Image size 1932x1932. Color fundus photograph
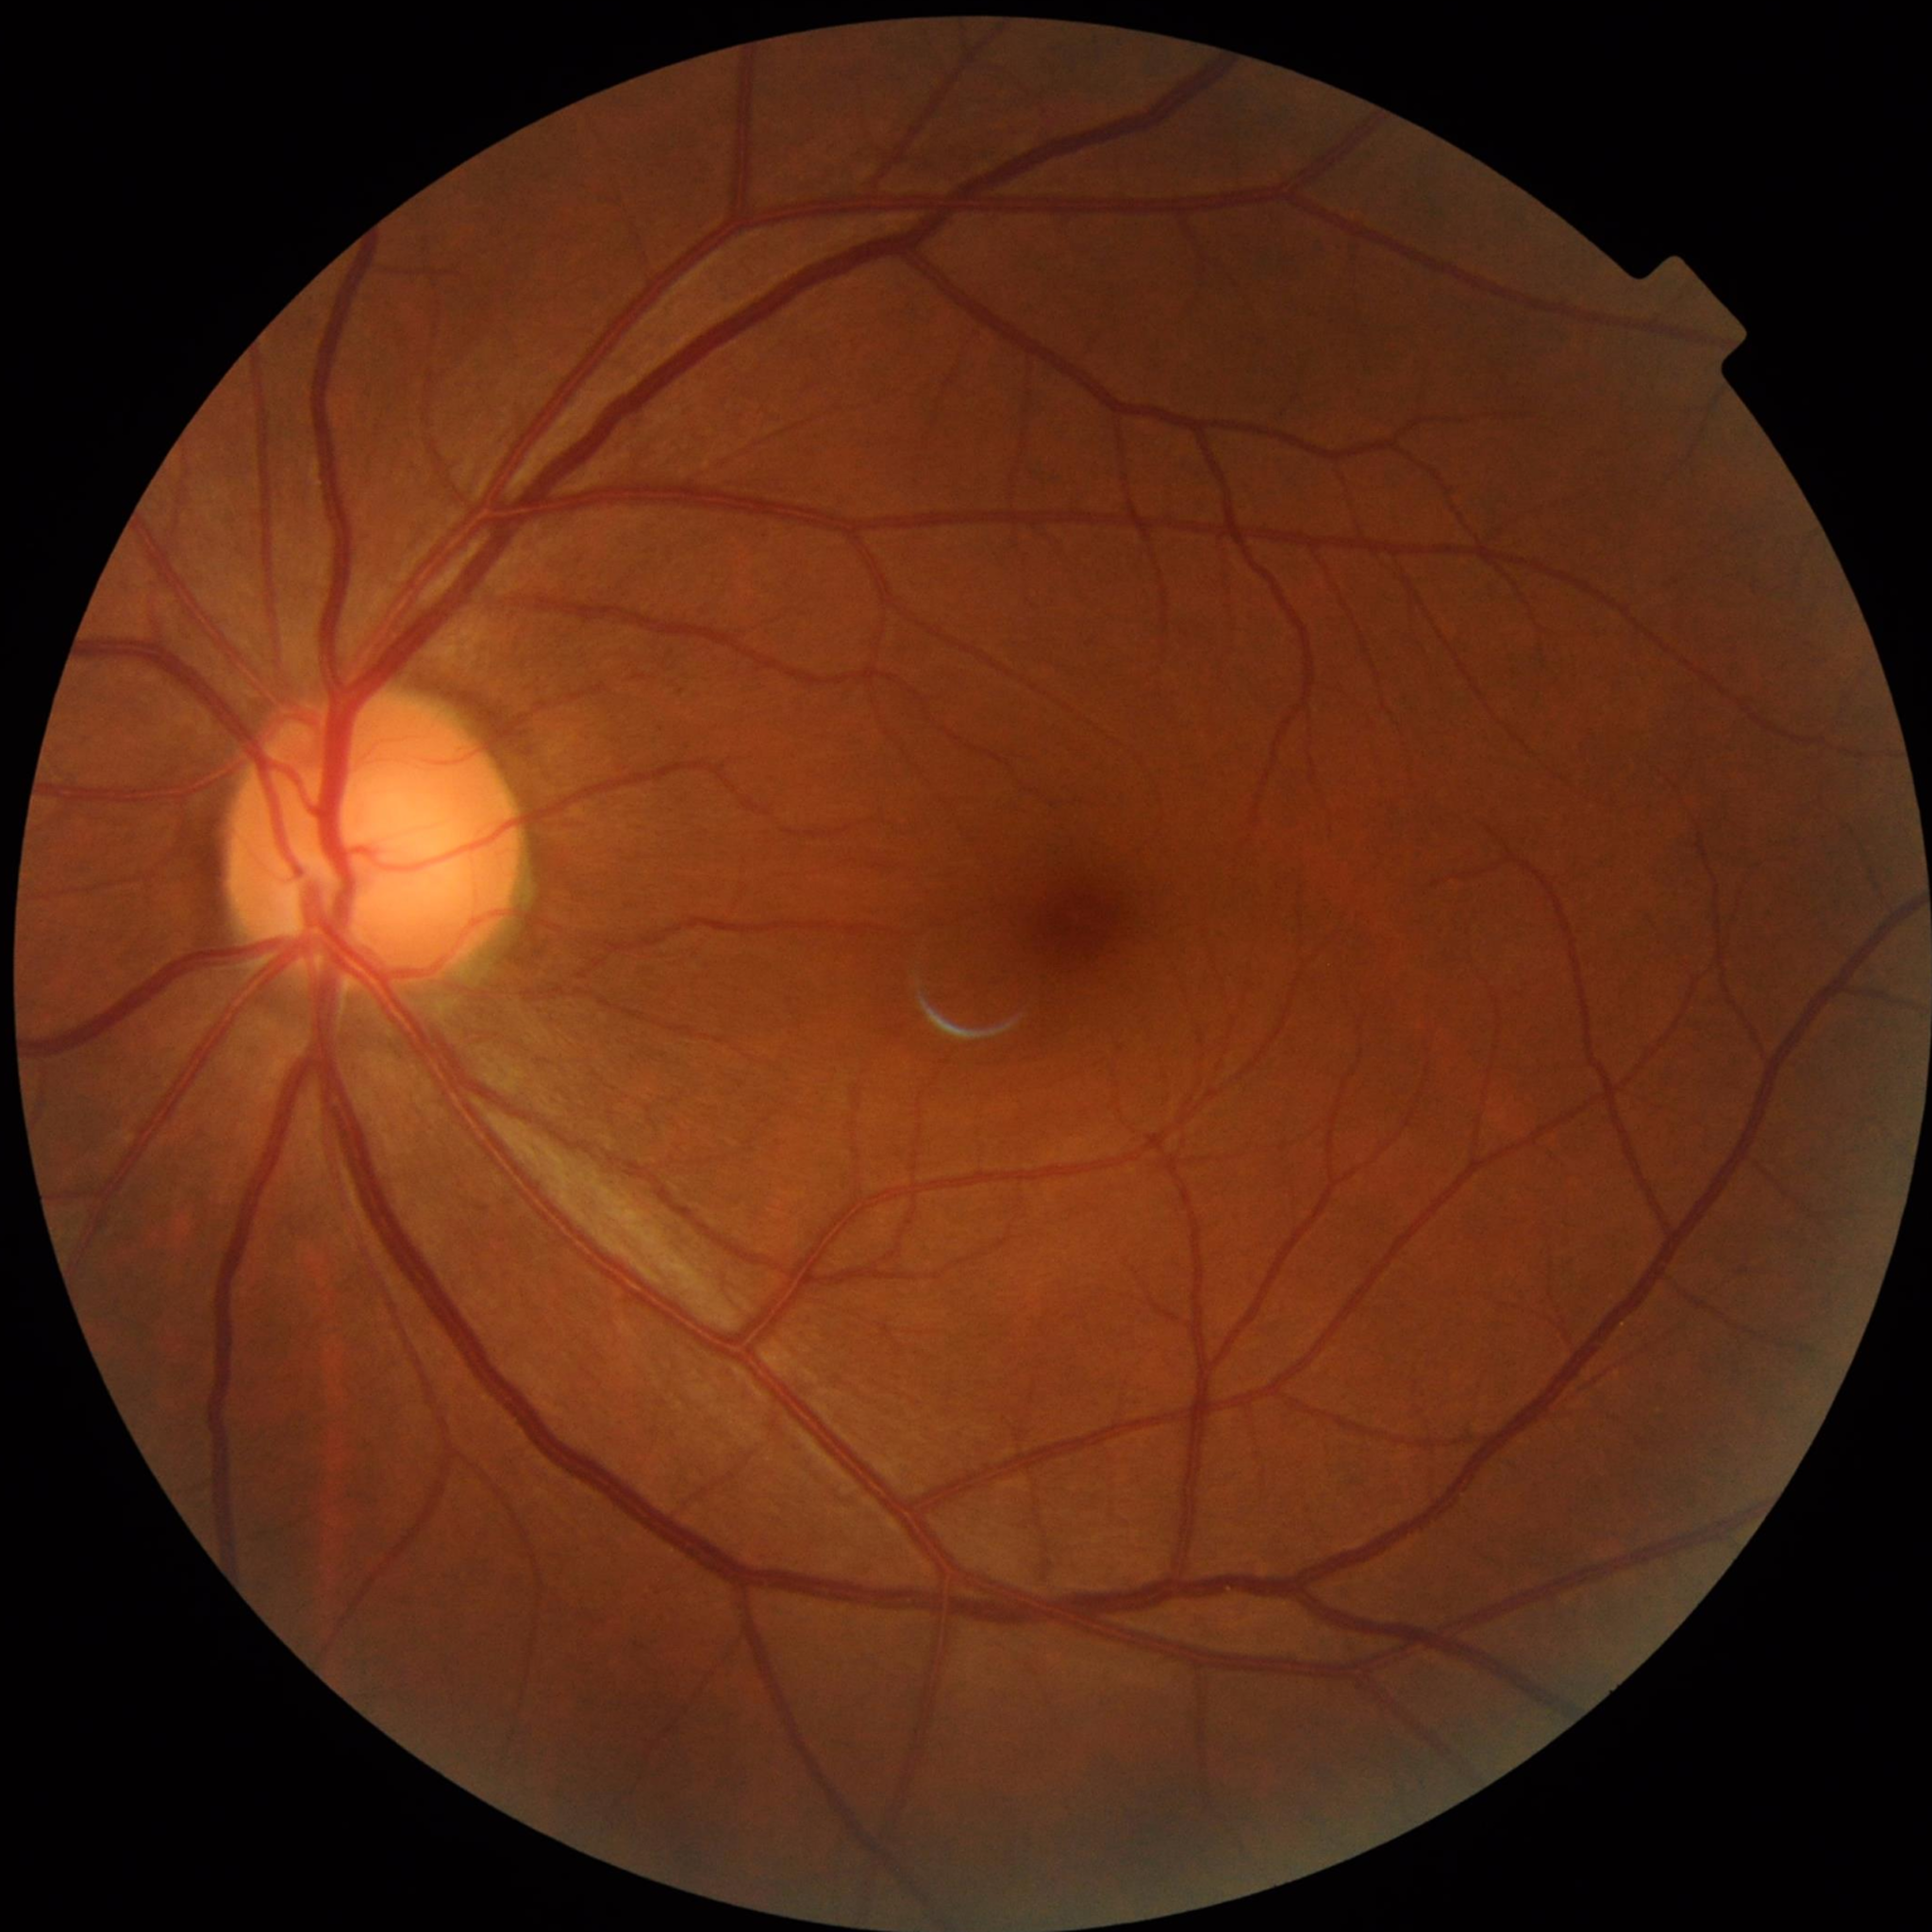 Diagnosis = no AMD, diabetic retinopathy, or glaucoma